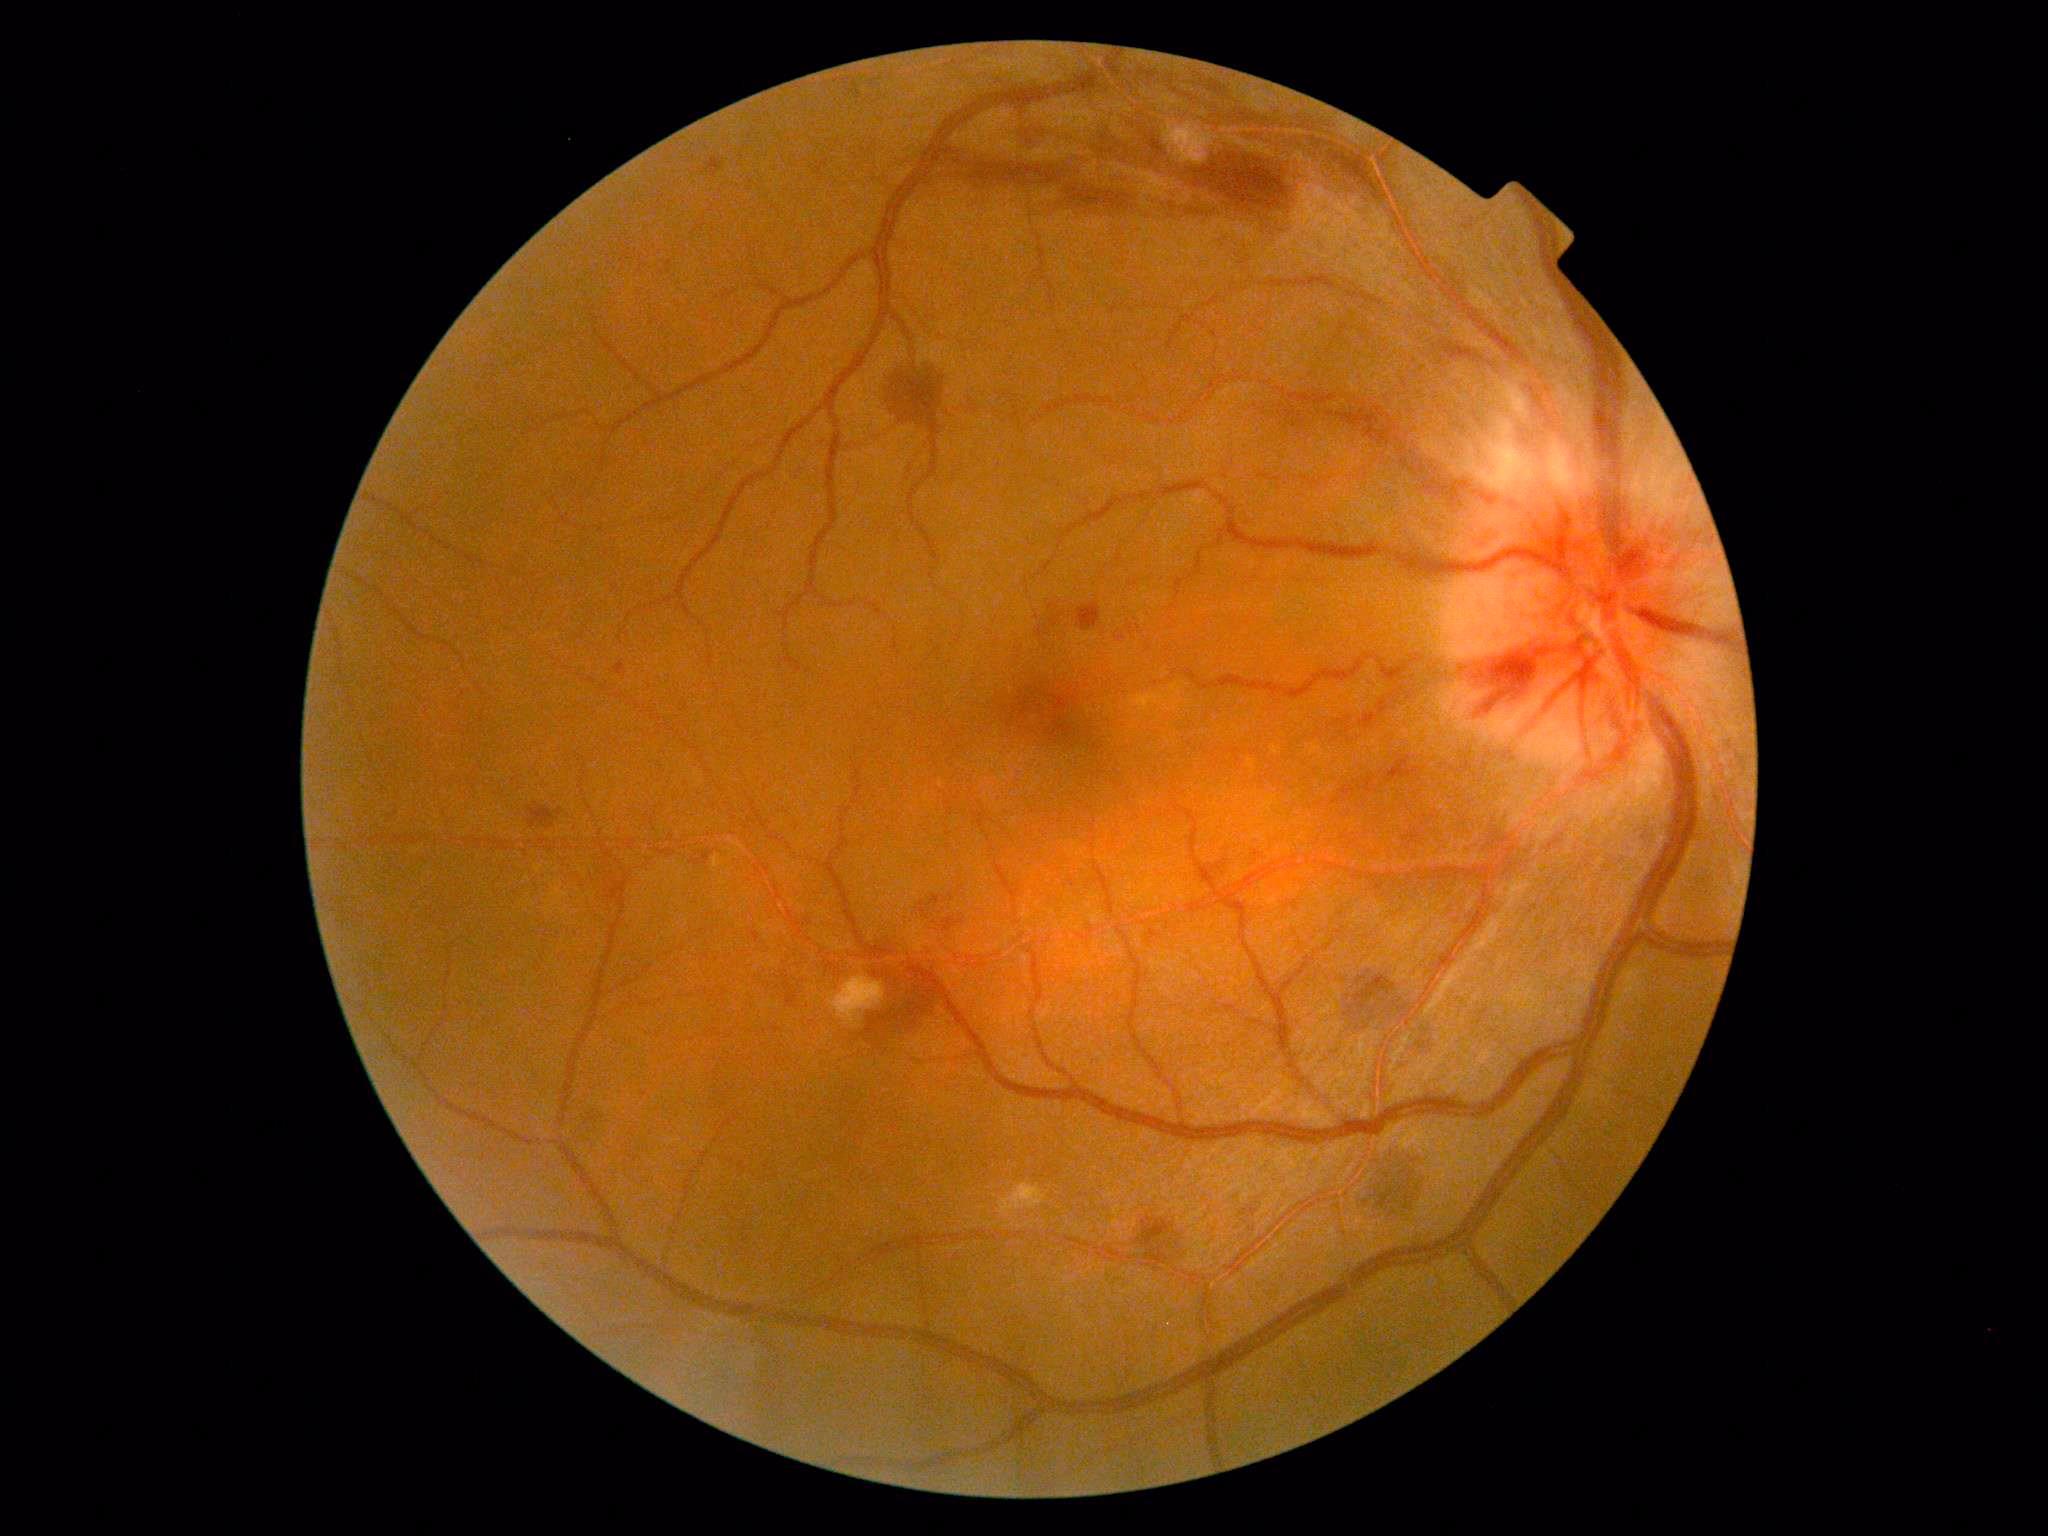
{"dr_grade": "grade 2"}